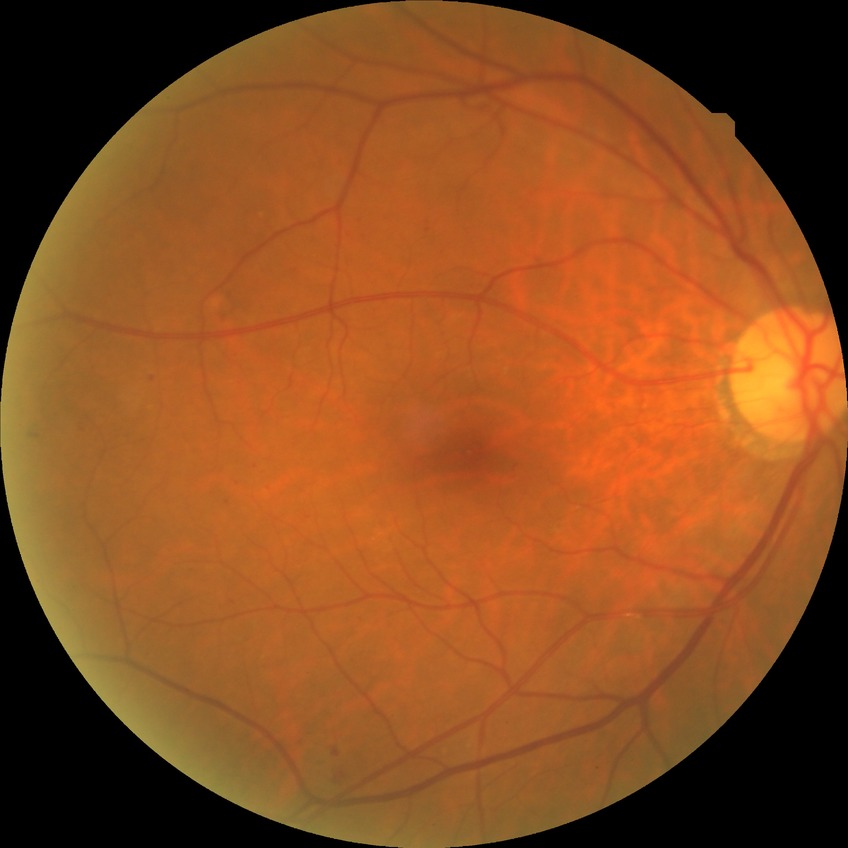

Retinopathy stage: no diabetic retinopathy.